FOV: 45 degrees; 2212x1659px
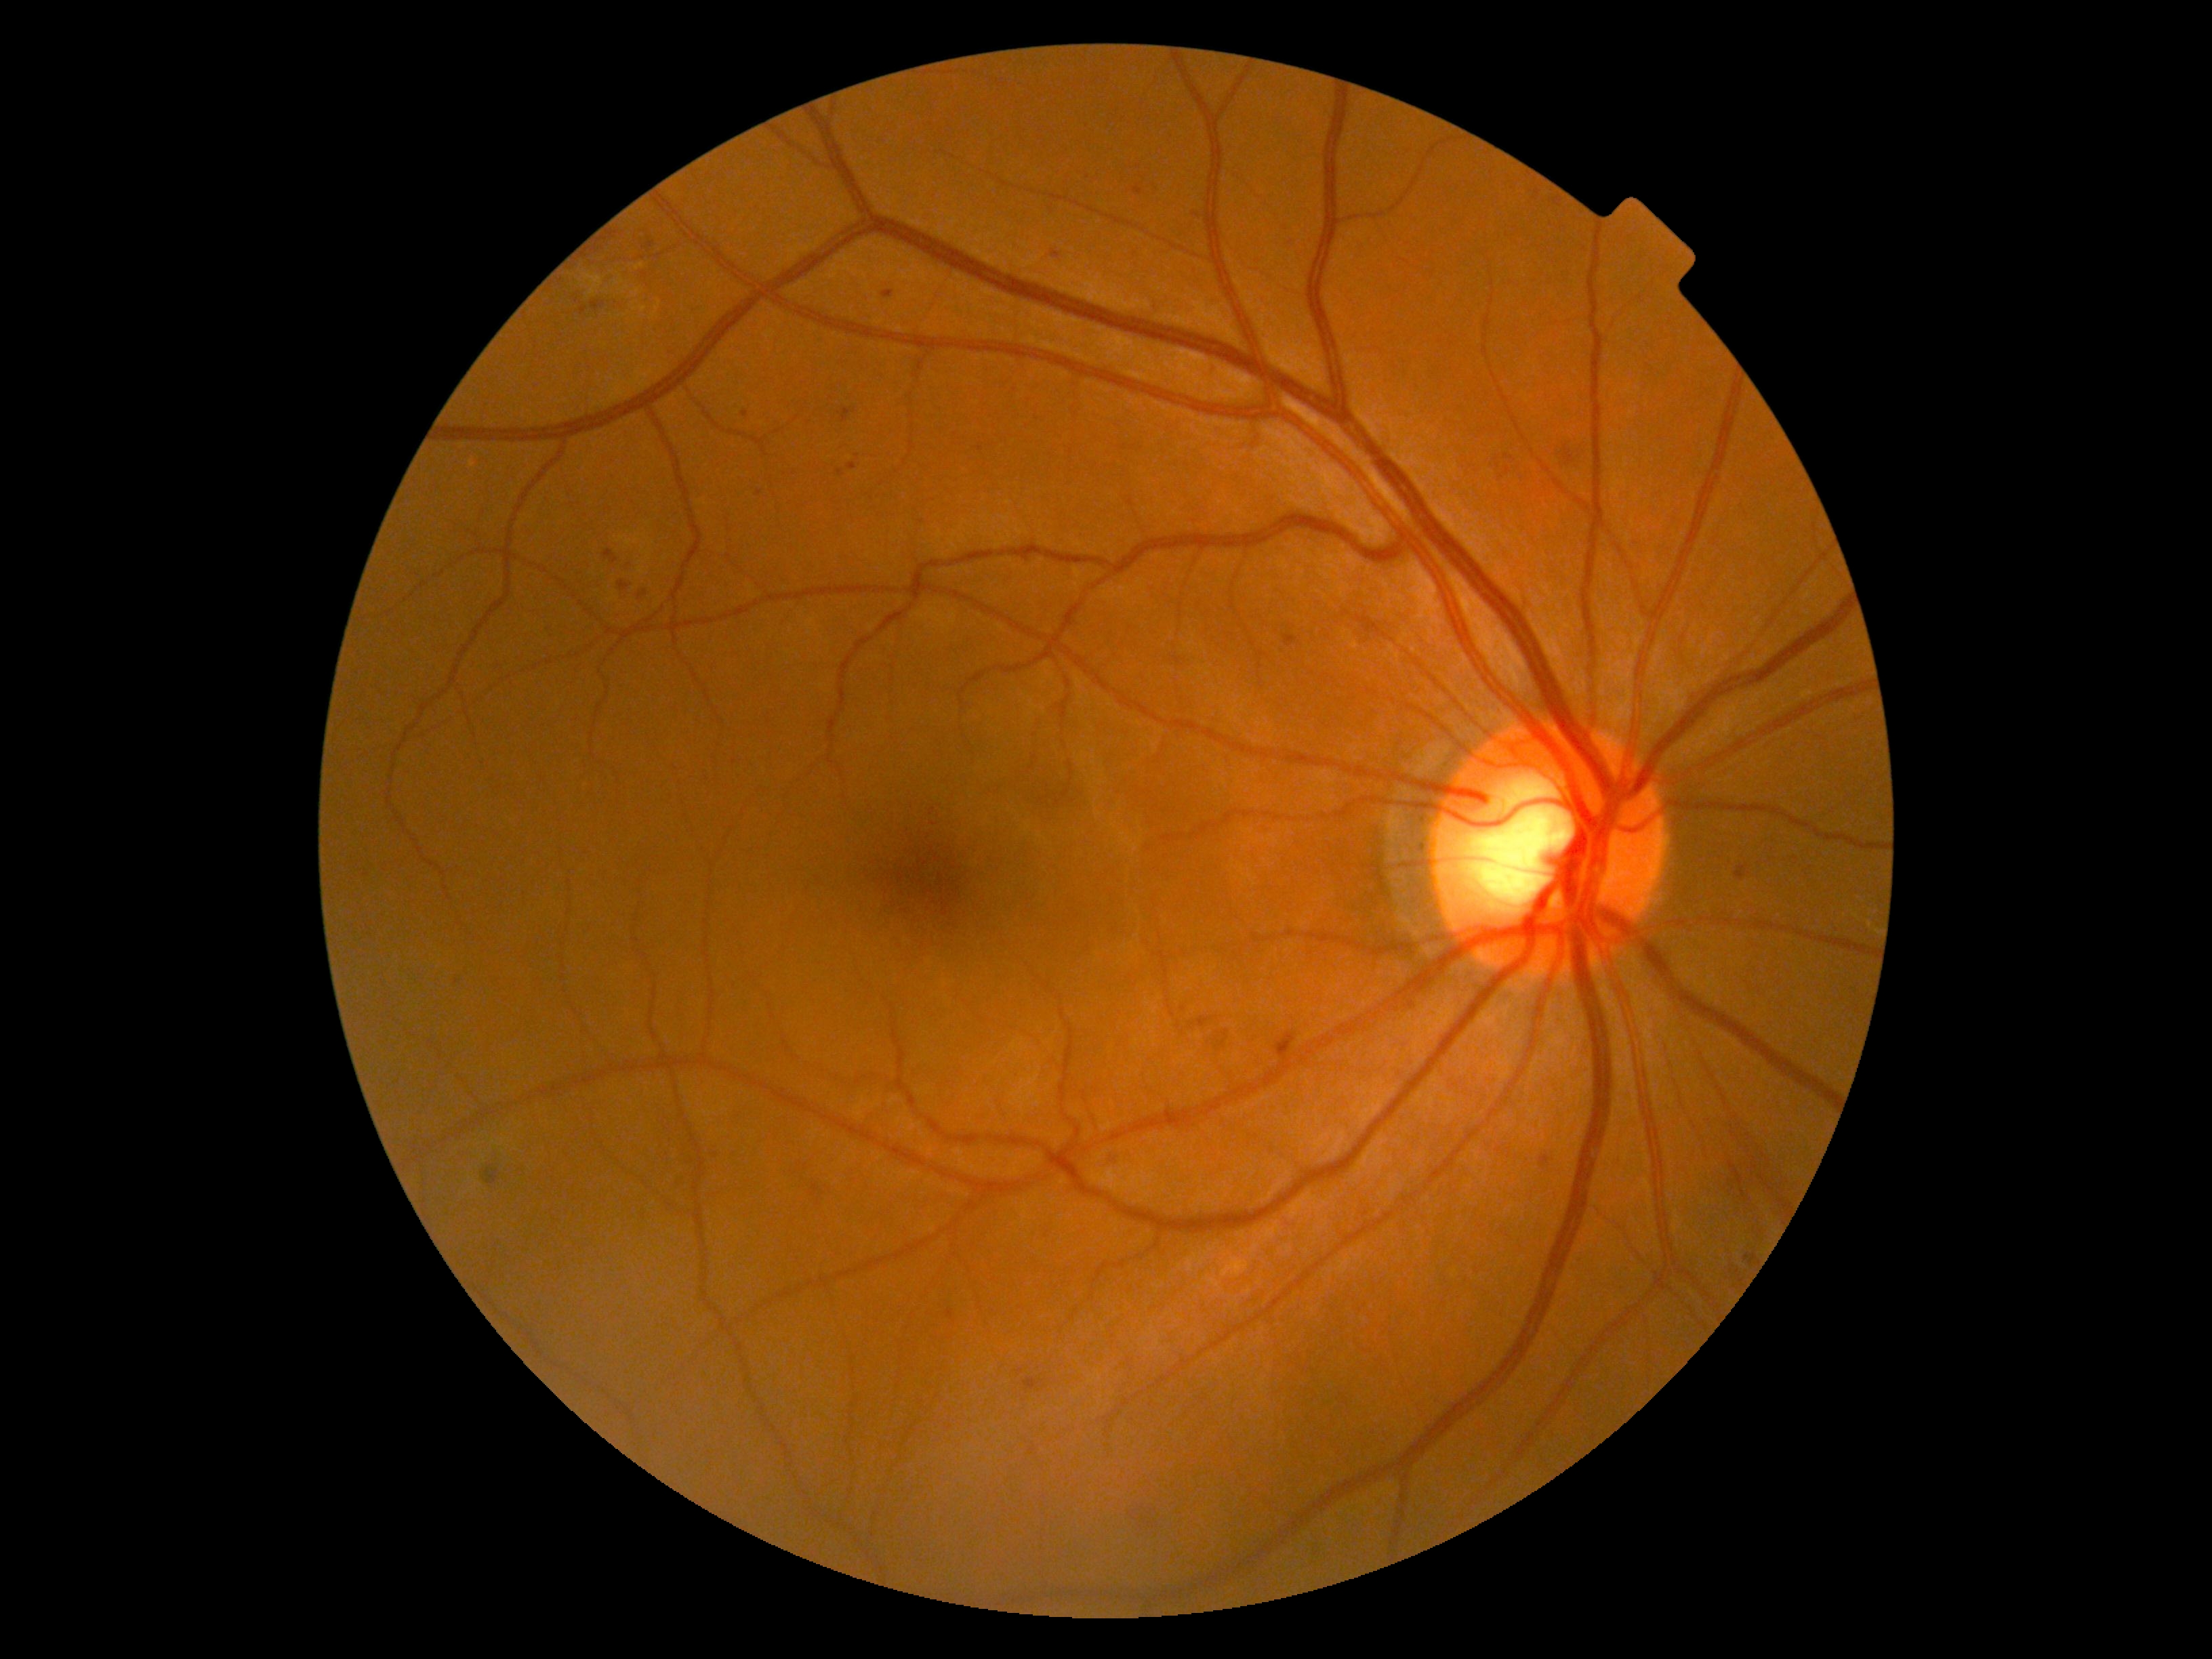

{"dr_grade": "grade 2 (moderate NPDR) — more than just microaneurysms but less than severe NPDR"}